Color fundus photograph
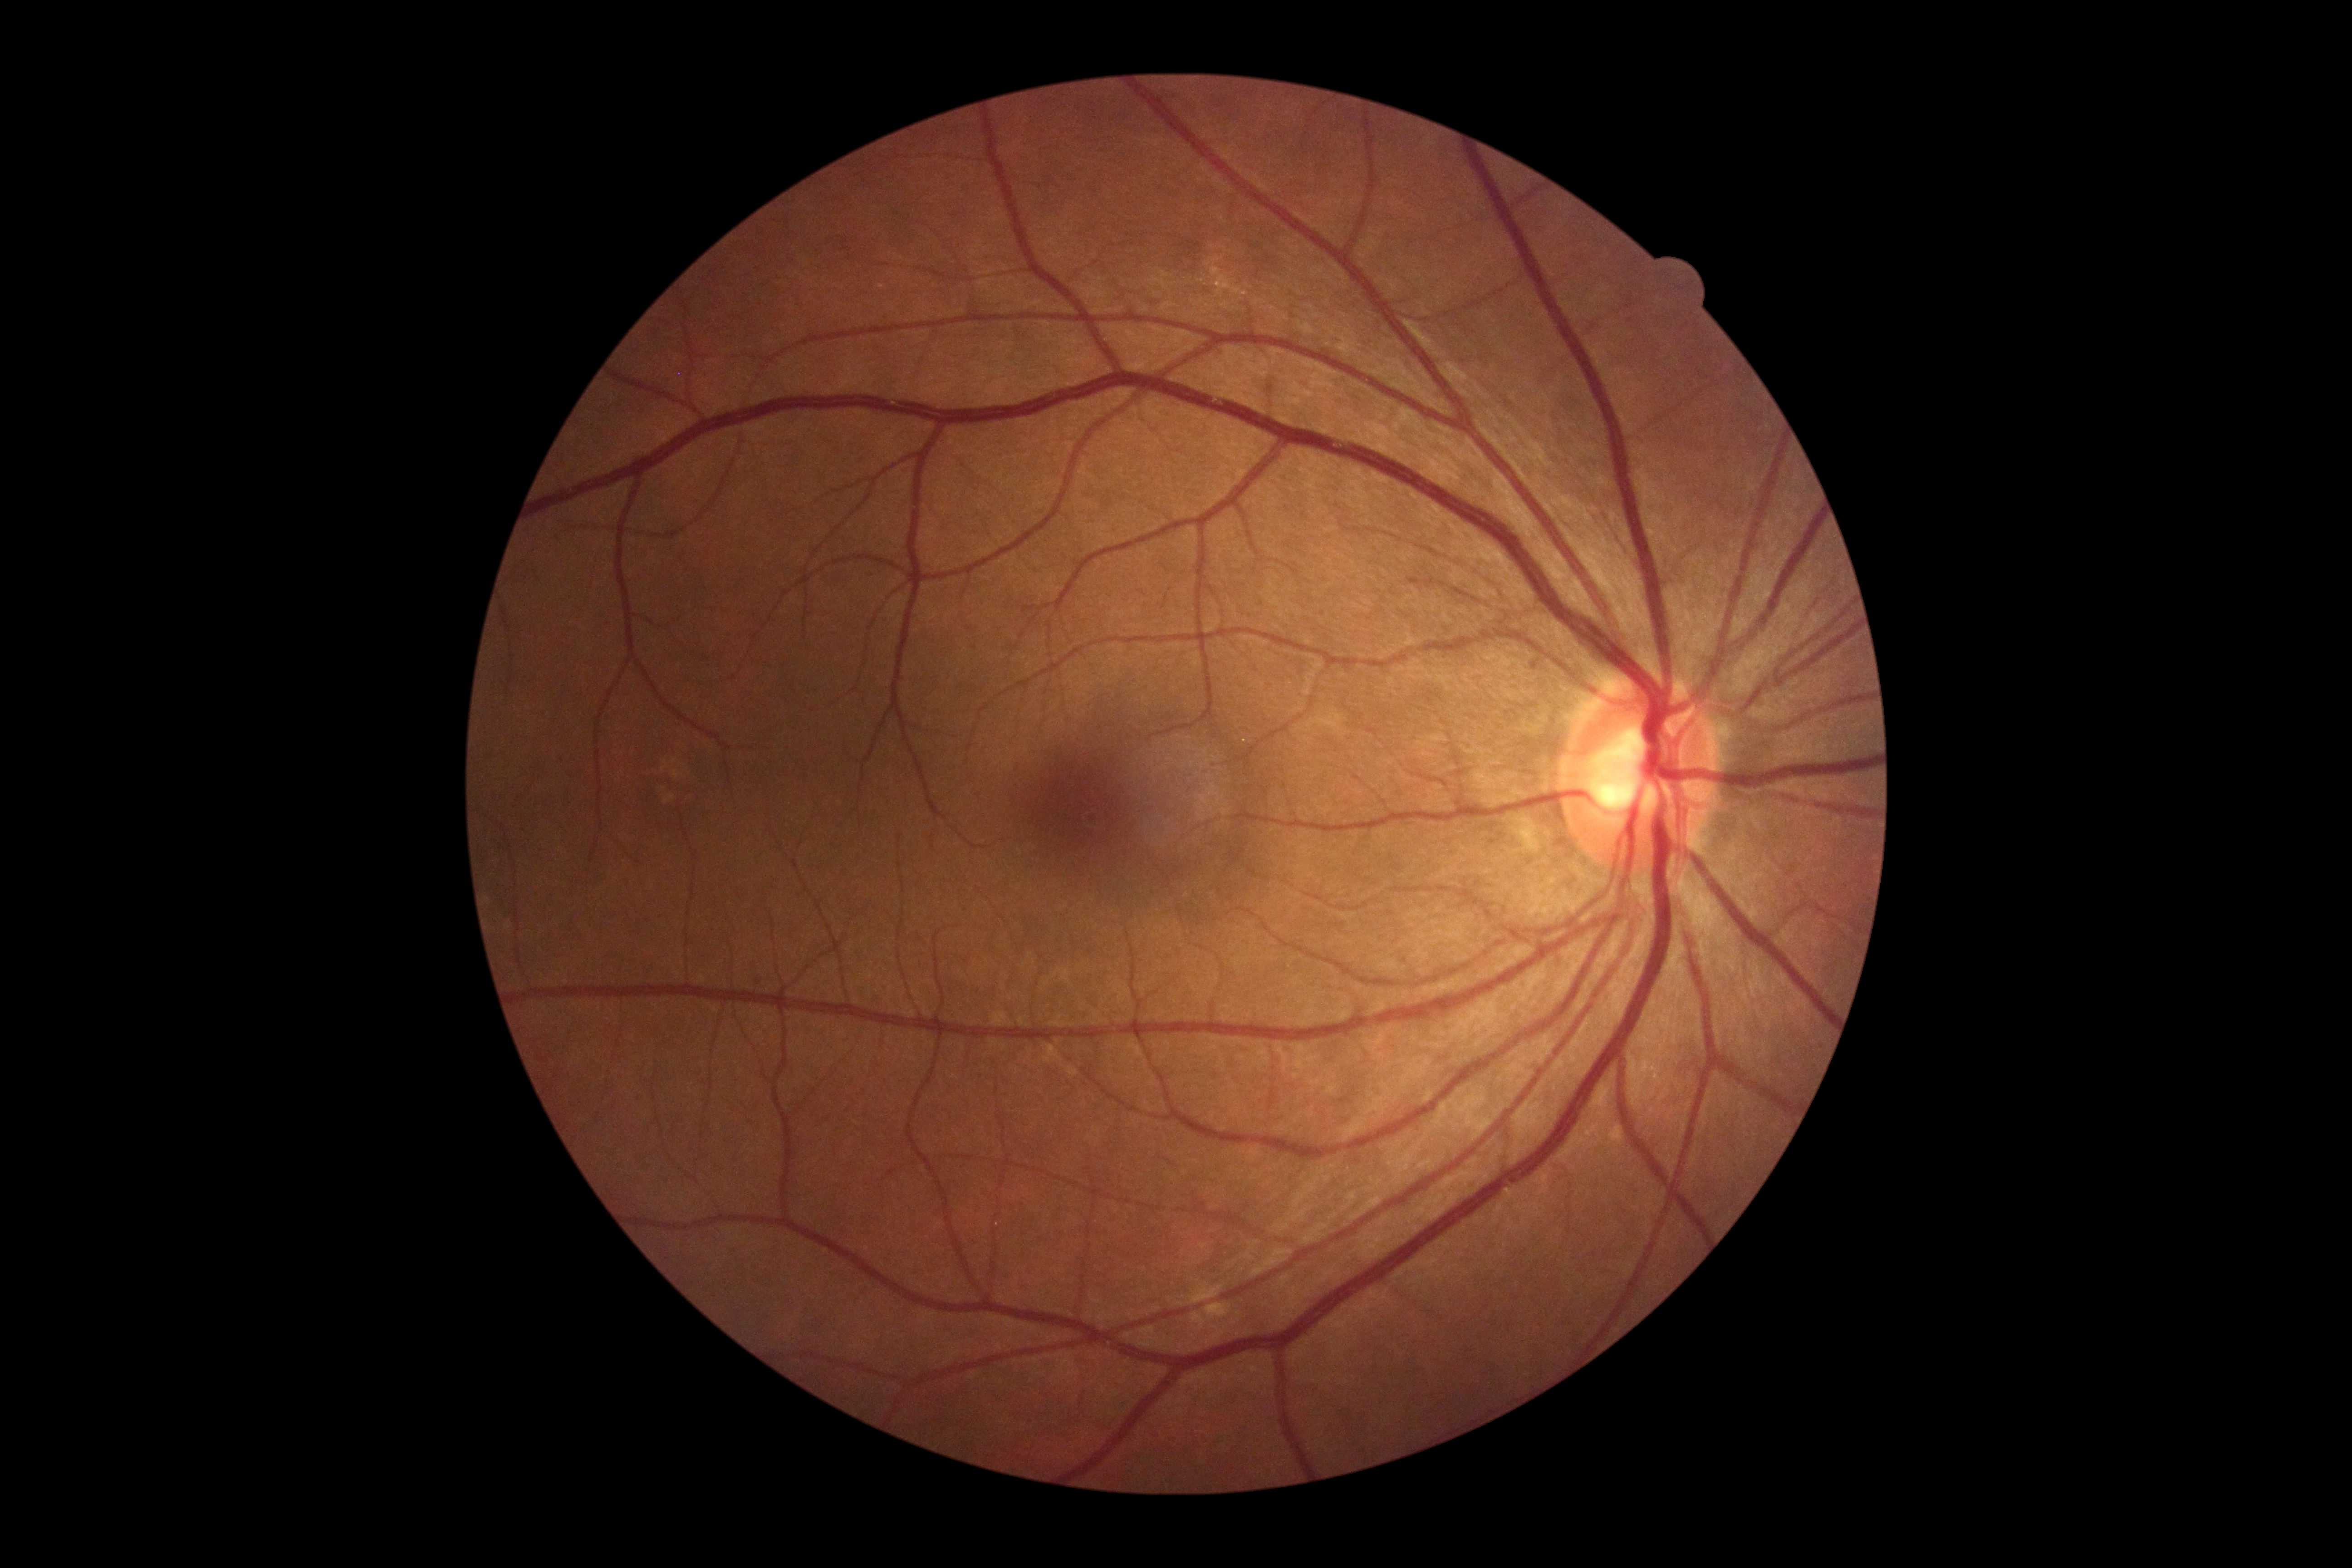 DR severity@0, DR impression@no apparent DR.